45-degree field of view.
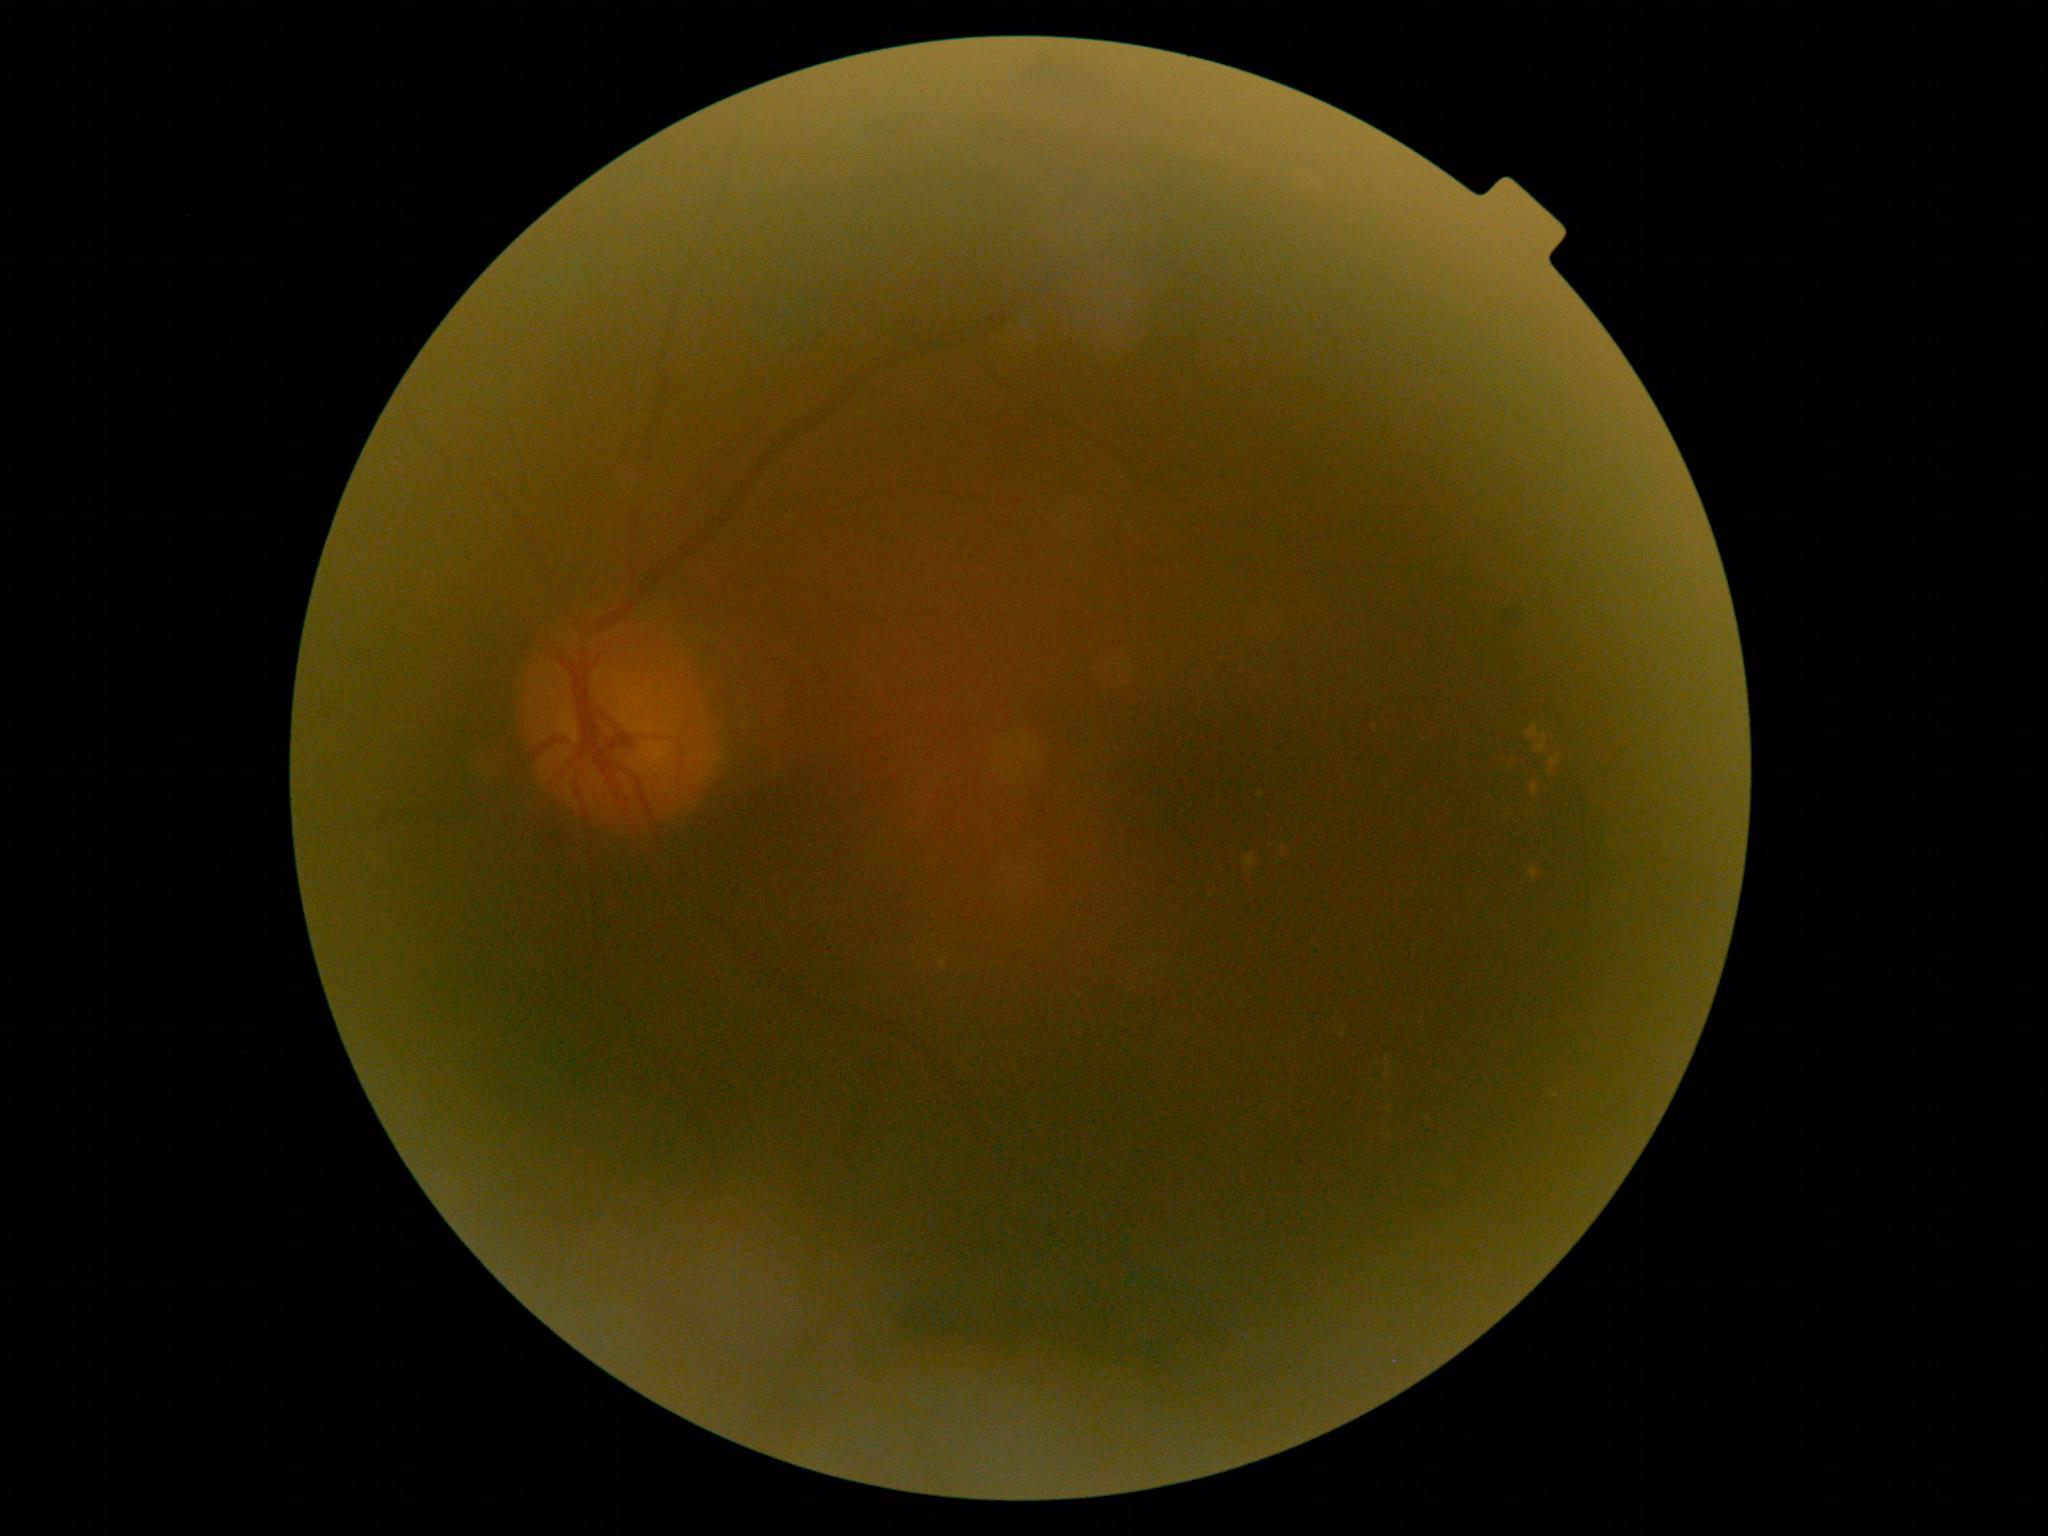 Diabetic retinopathy grade: 2 (moderate NPDR).